Nonmydriatic fundus photograph; 848 by 848 pixels; camera: NIDEK AFC-230; 45 degree fundus photograph.
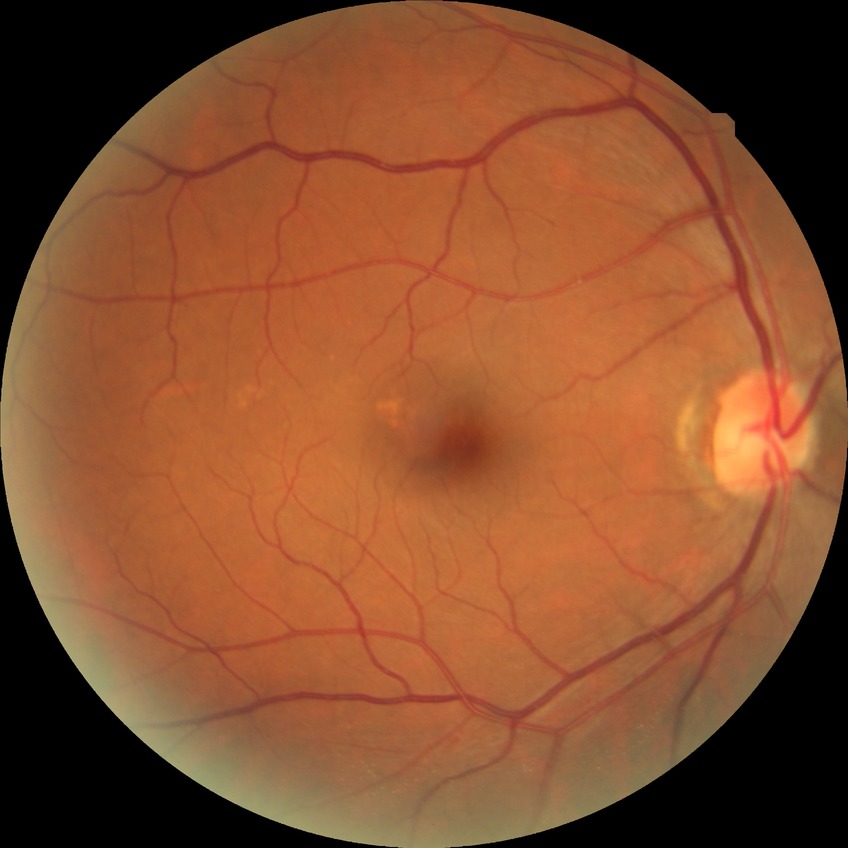 diabetic retinopathy stage: no diabetic retinopathy.